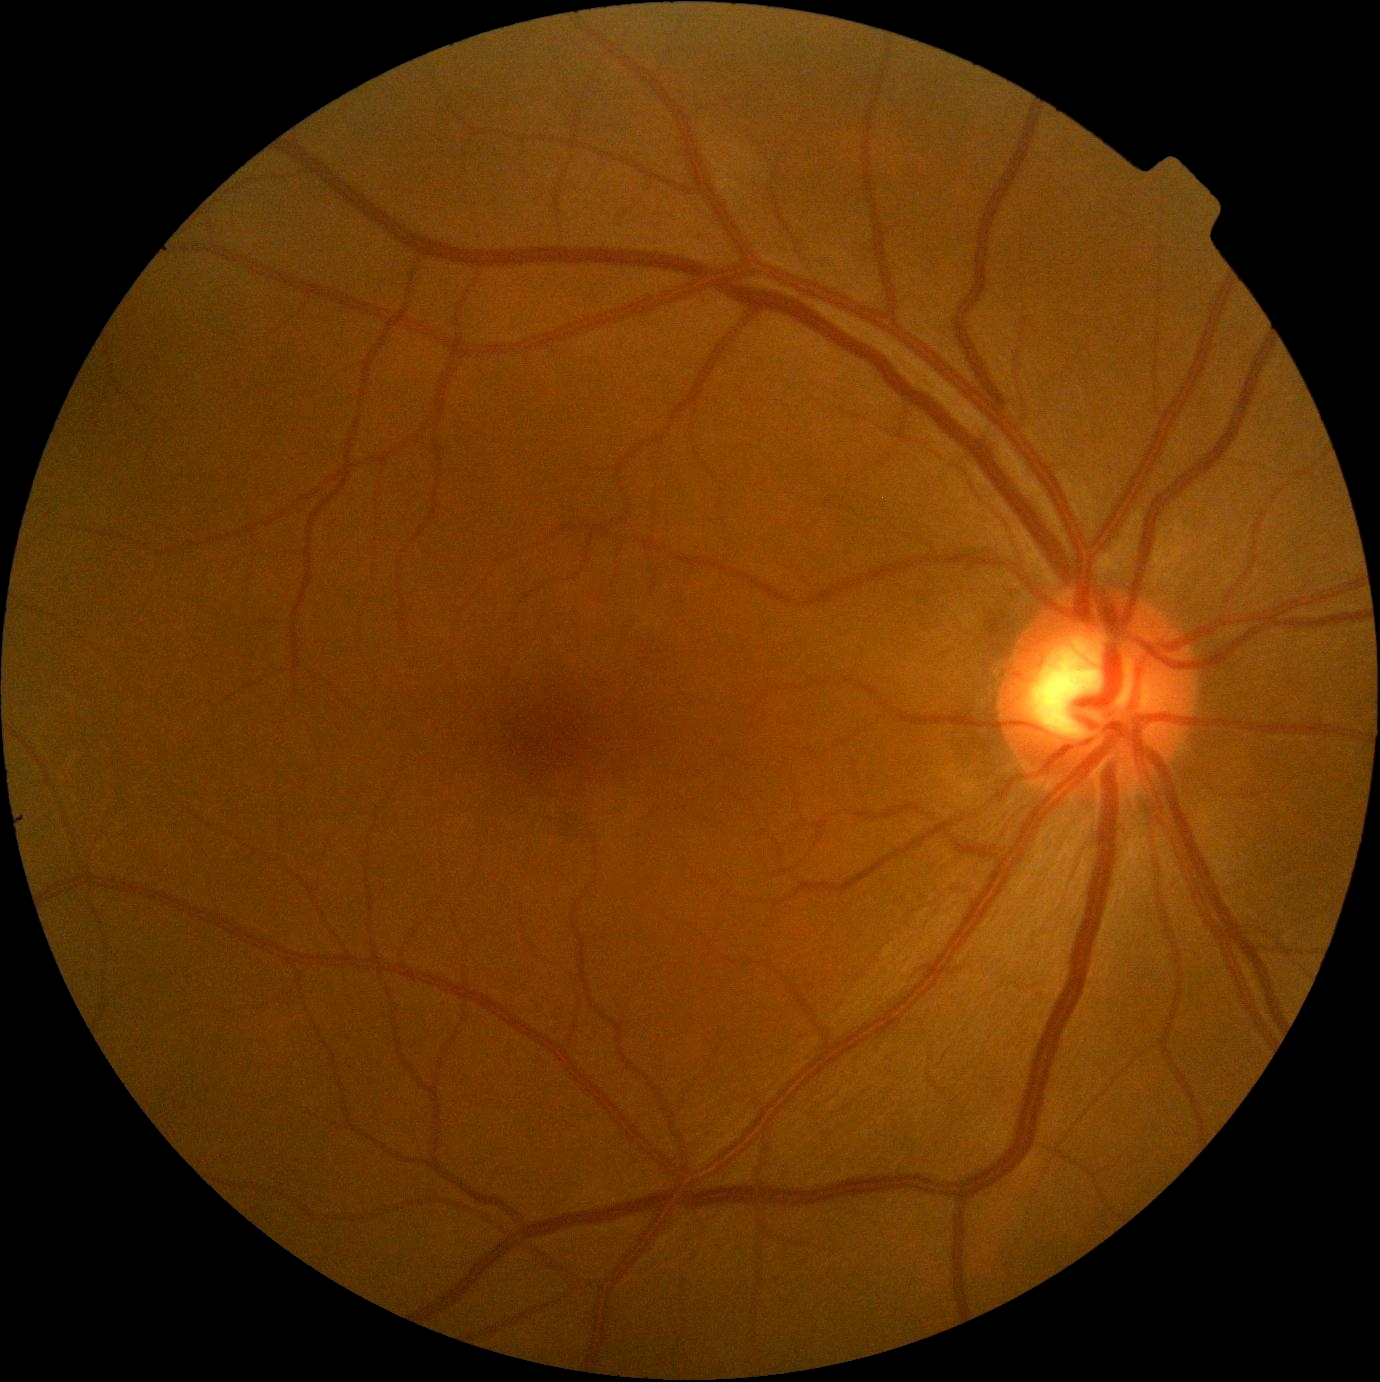
dr_impression: negative for DR
dr_grade: no apparent diabetic retinopathy (0) — no visible signs of diabetic retinopathy